45° FOV:
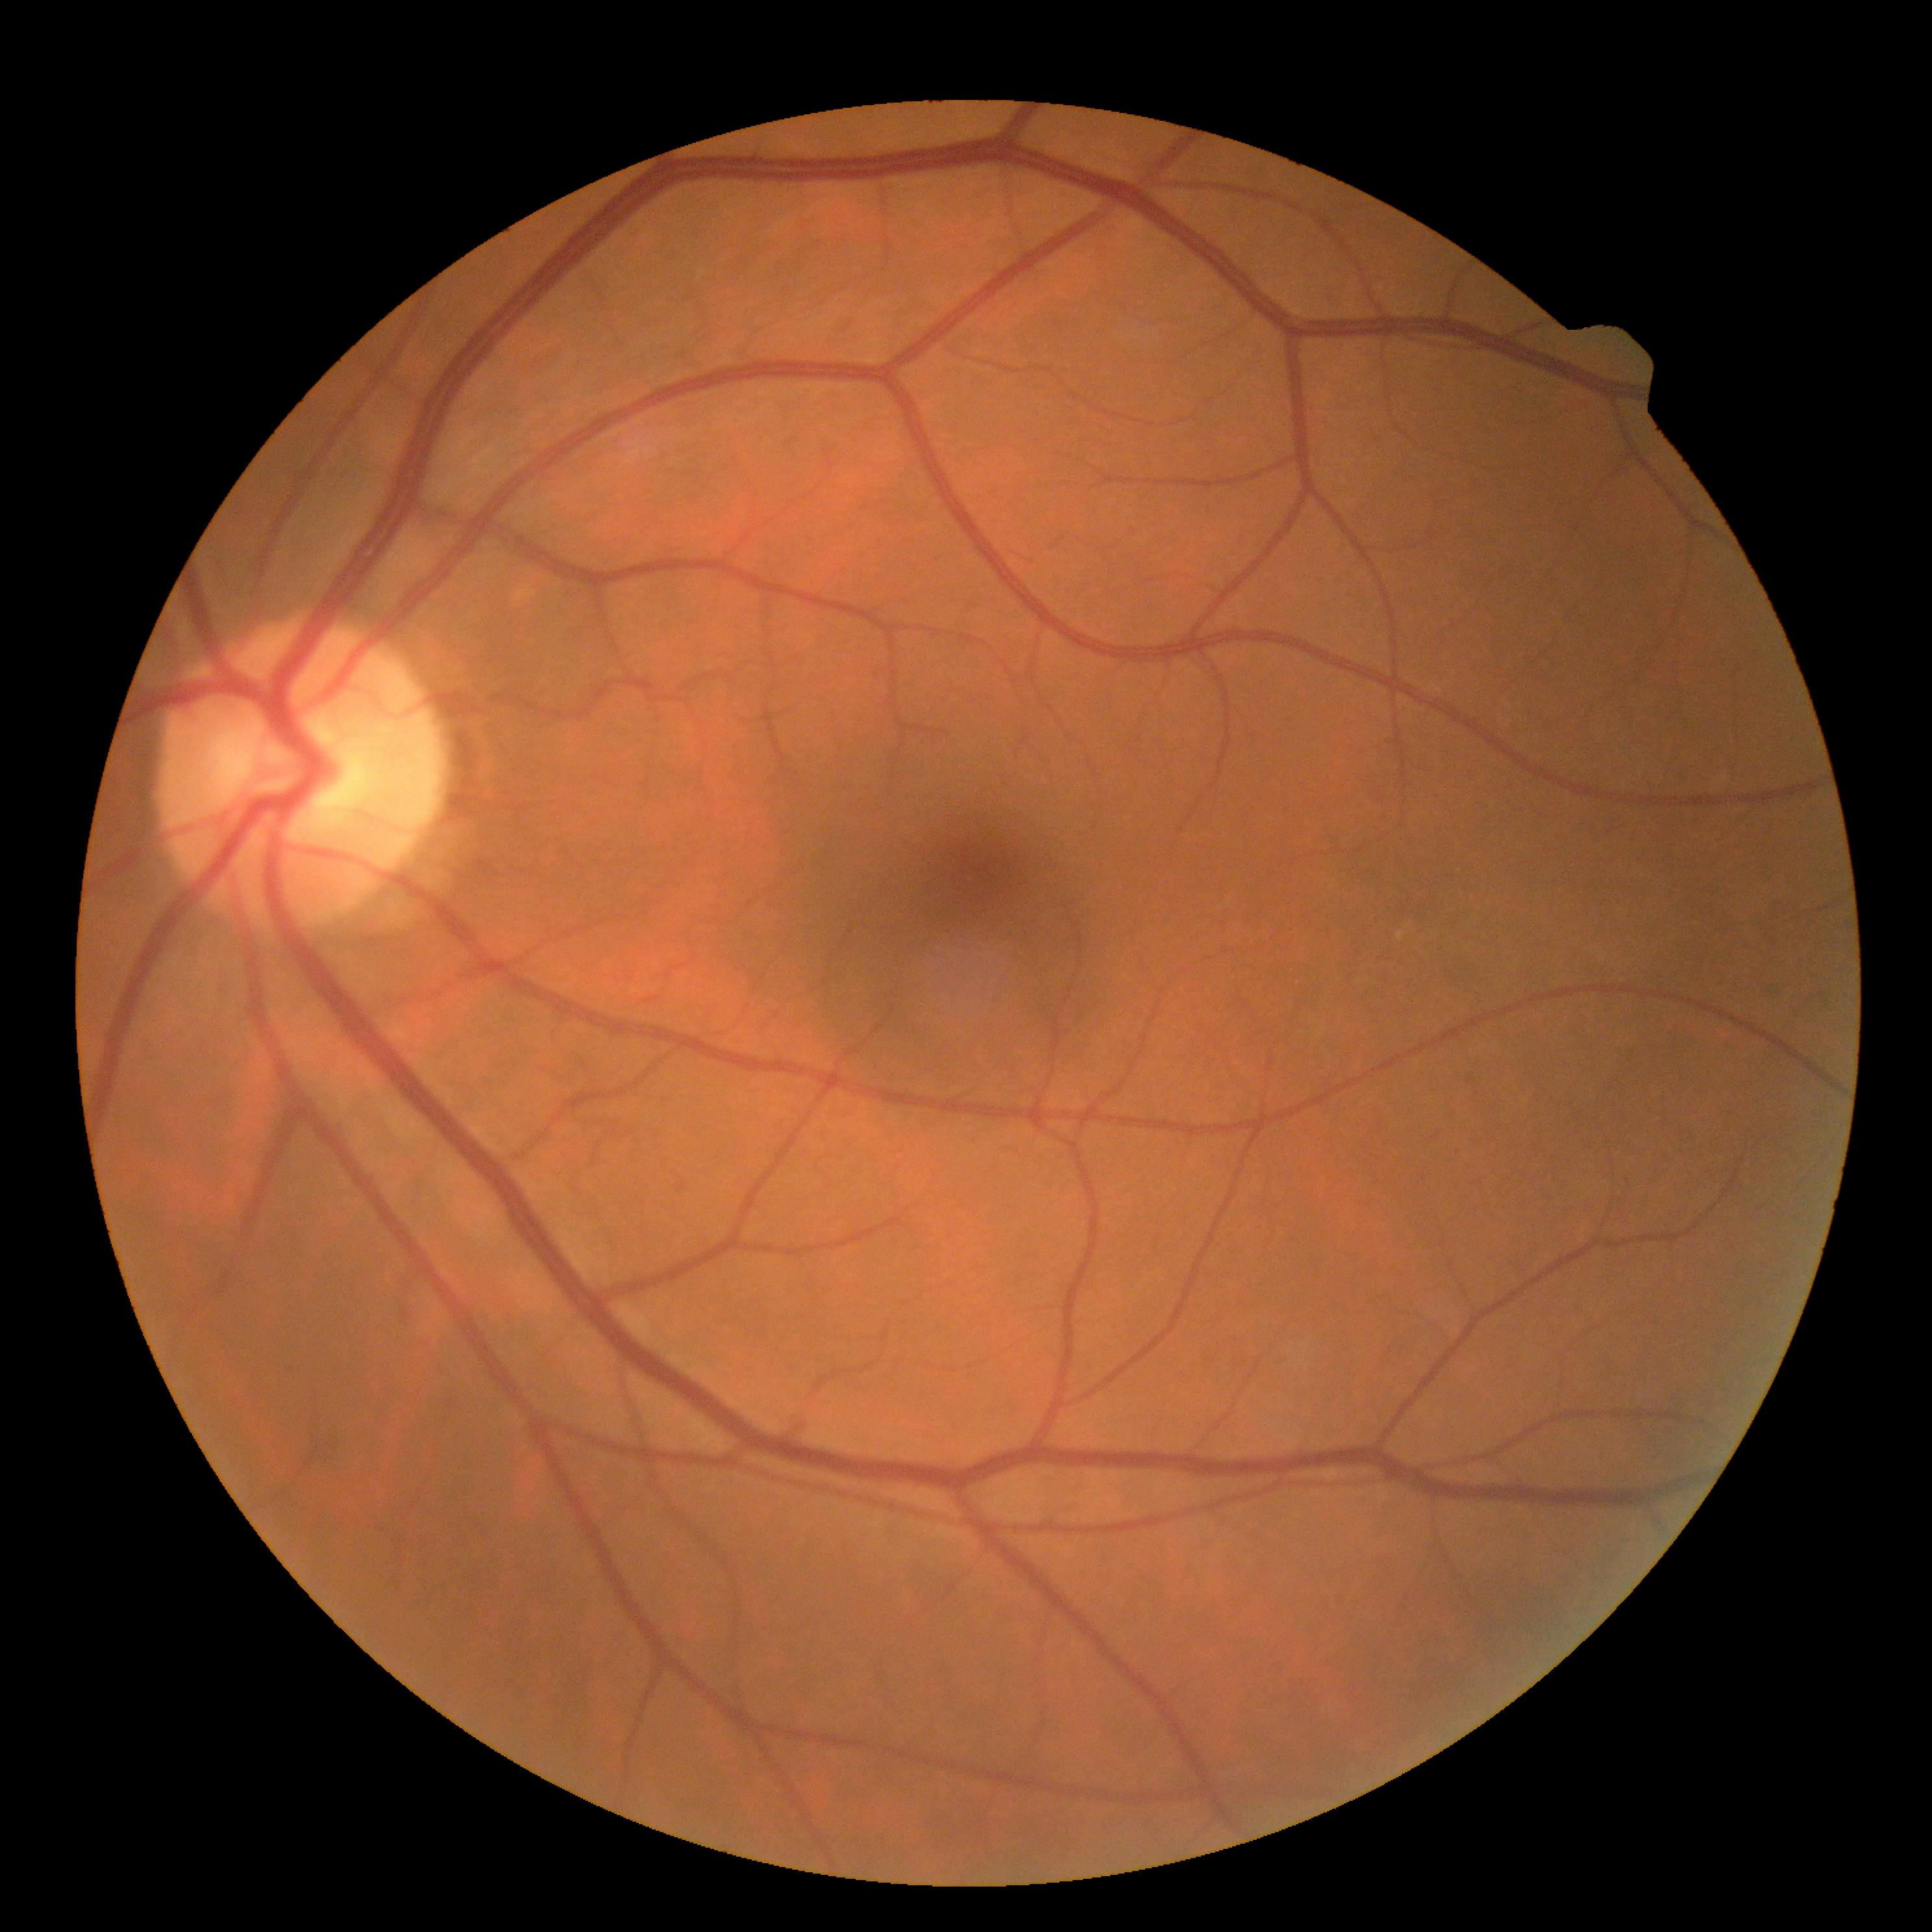 Diabetic retinopathy (DR): no apparent retinopathy (grade 0).